FOV: 45 degrees · 2212 by 1659 pixels.
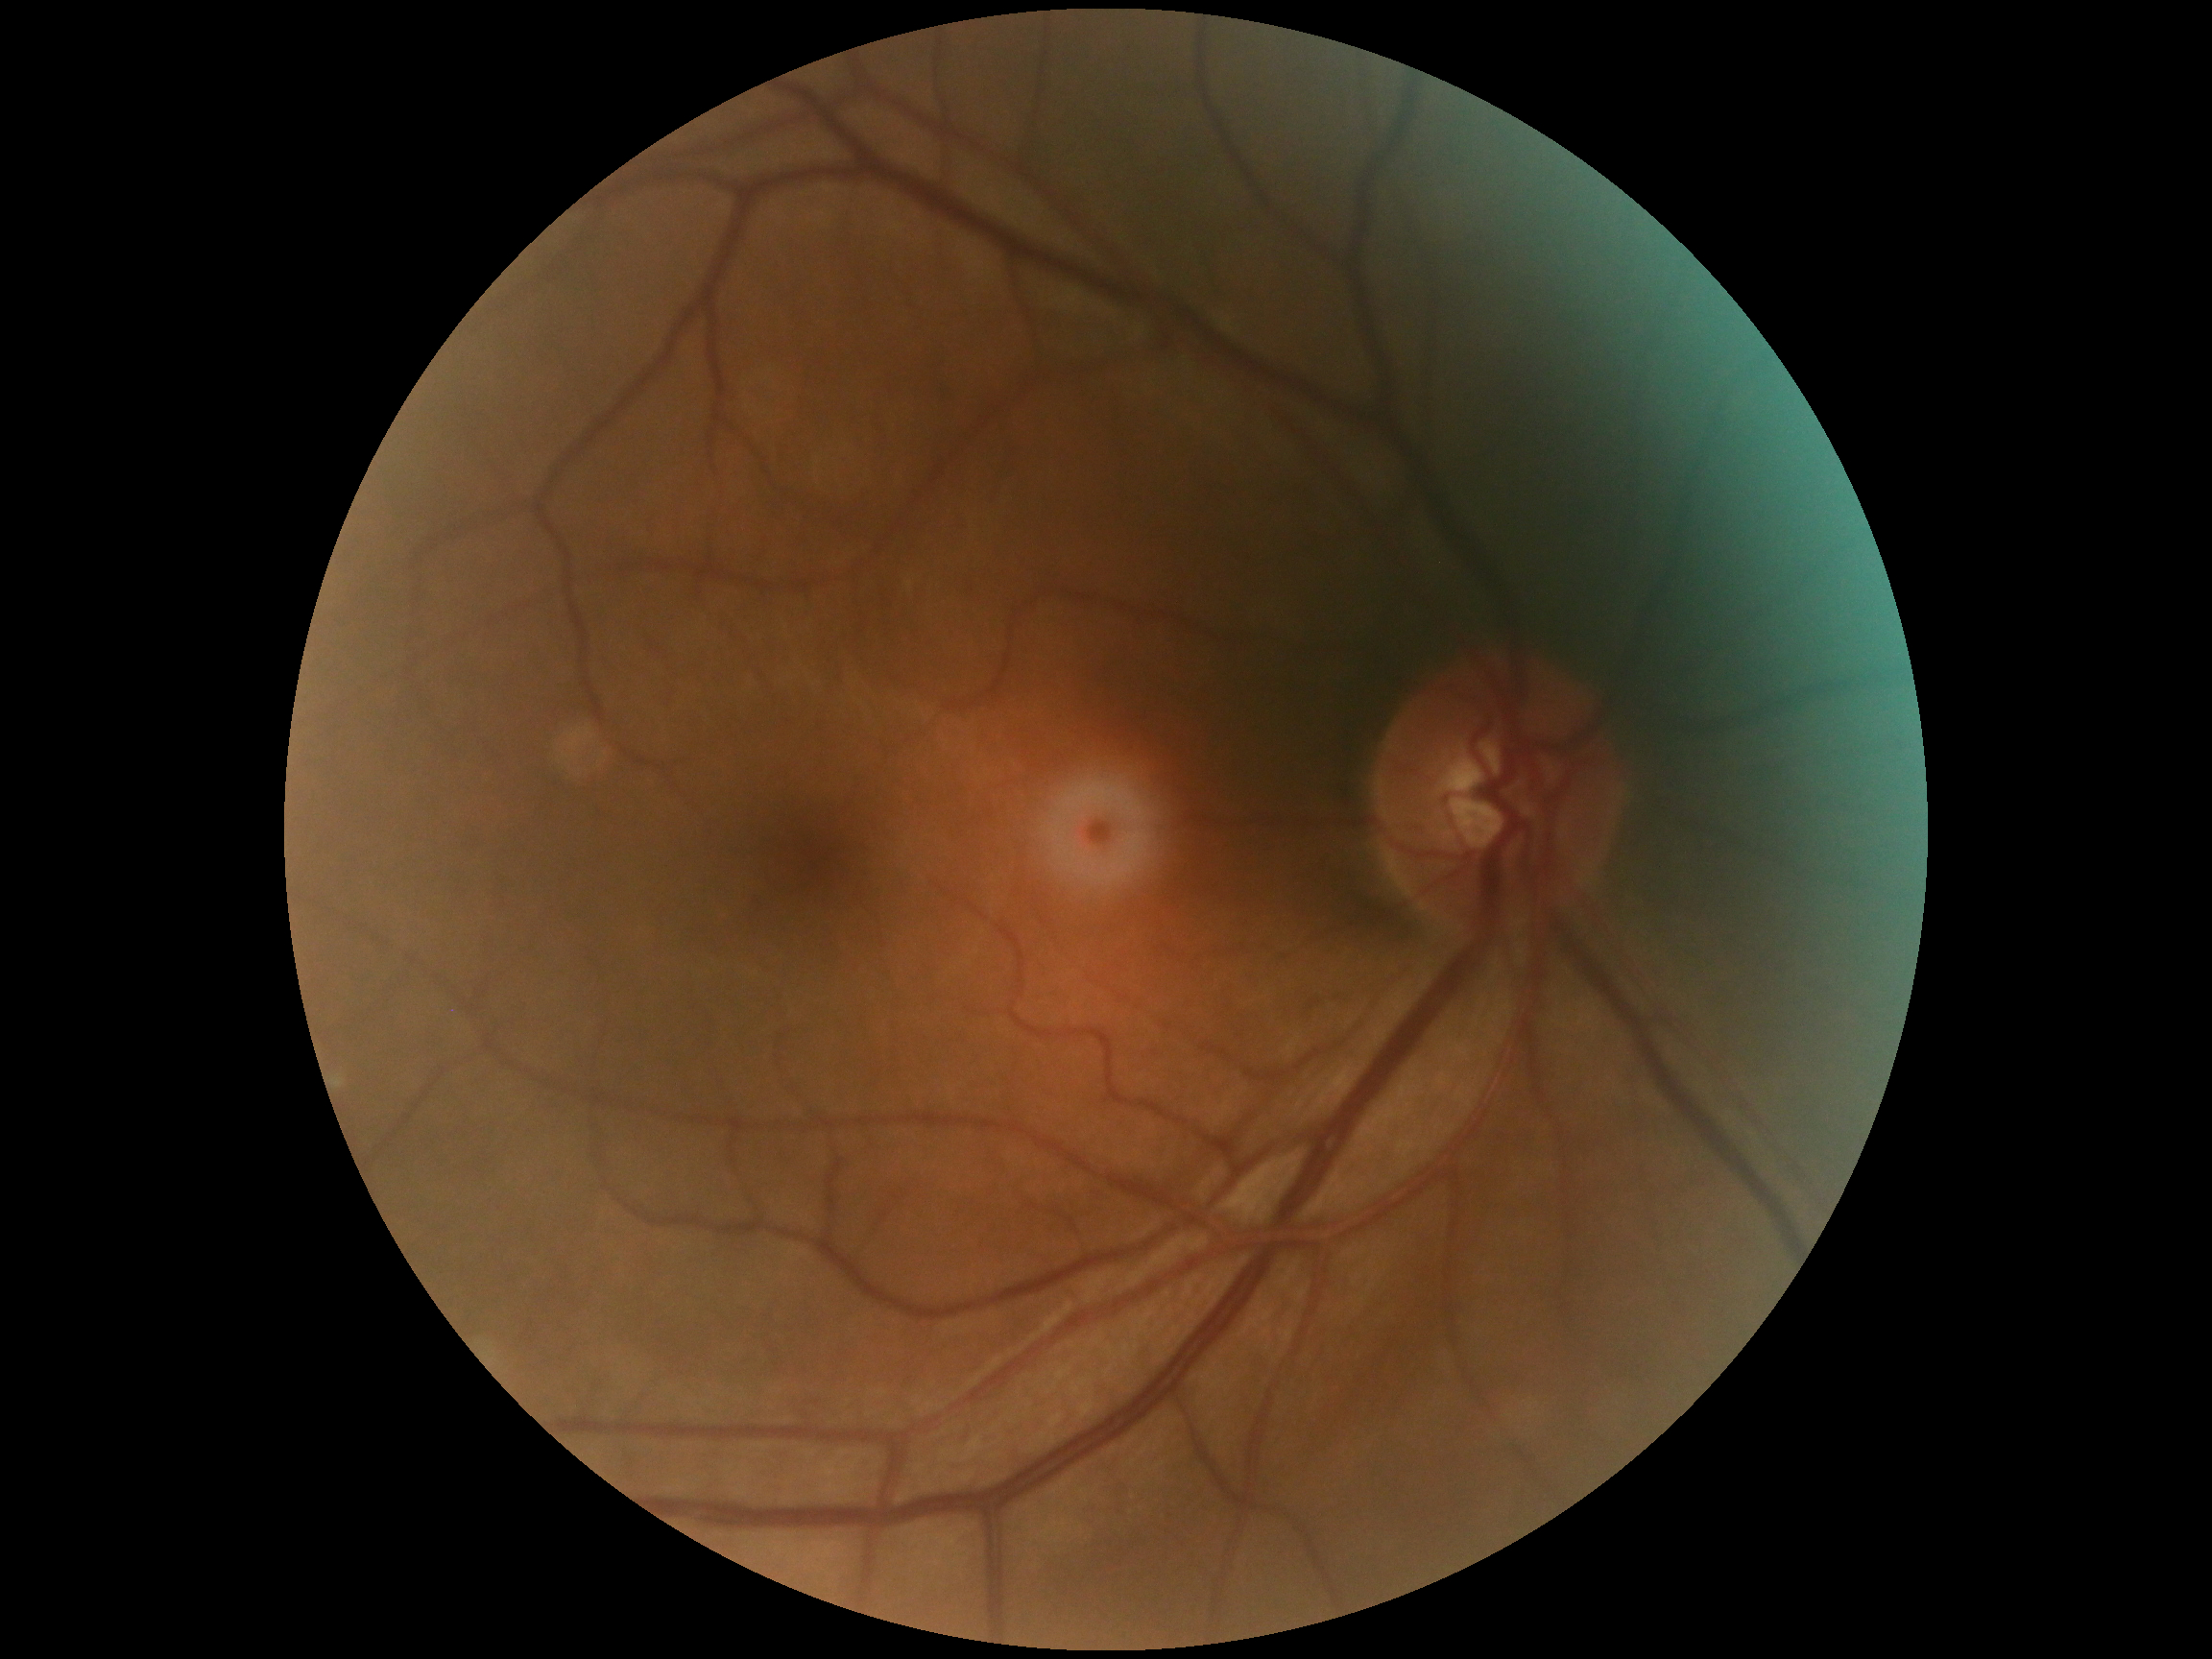

Retinopathy: no apparent diabetic retinopathy (grade 0).